512 by 512 pixels; retinal fundus photograph:
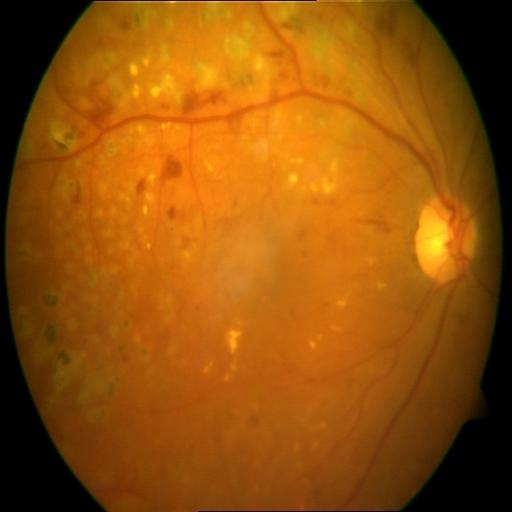
There is evidence of laser scars and hemorrhagic retinopathy.